Modified Davis classification.
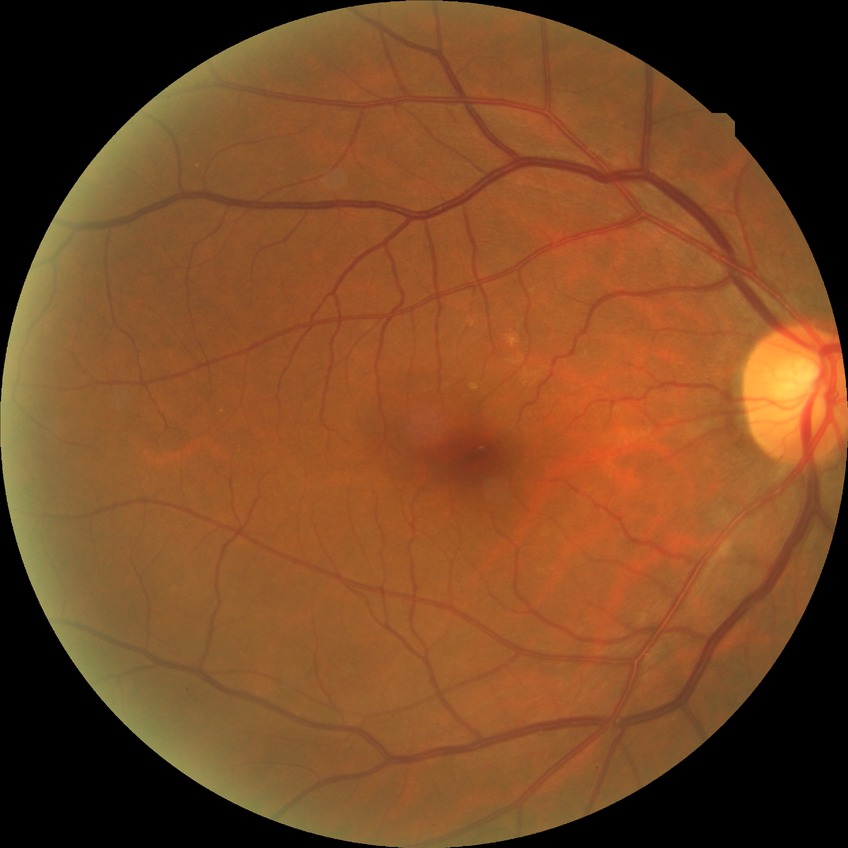
diabetic retinopathy (DR) = NDR (no diabetic retinopathy).